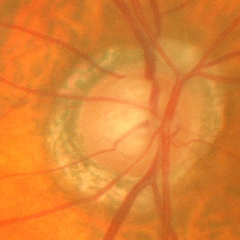
Findings consistent with glaucoma.
Early glaucomatous changes.